512 x 512 pixels.
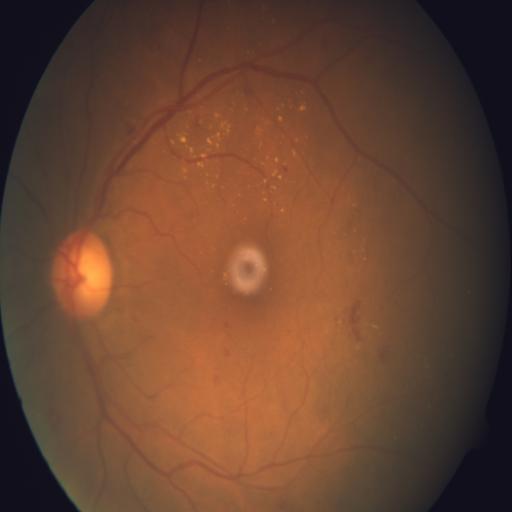

Abnormalities: hemorrhagic retinopathy (HR) | exudation (EDN).